45-degree field of view.
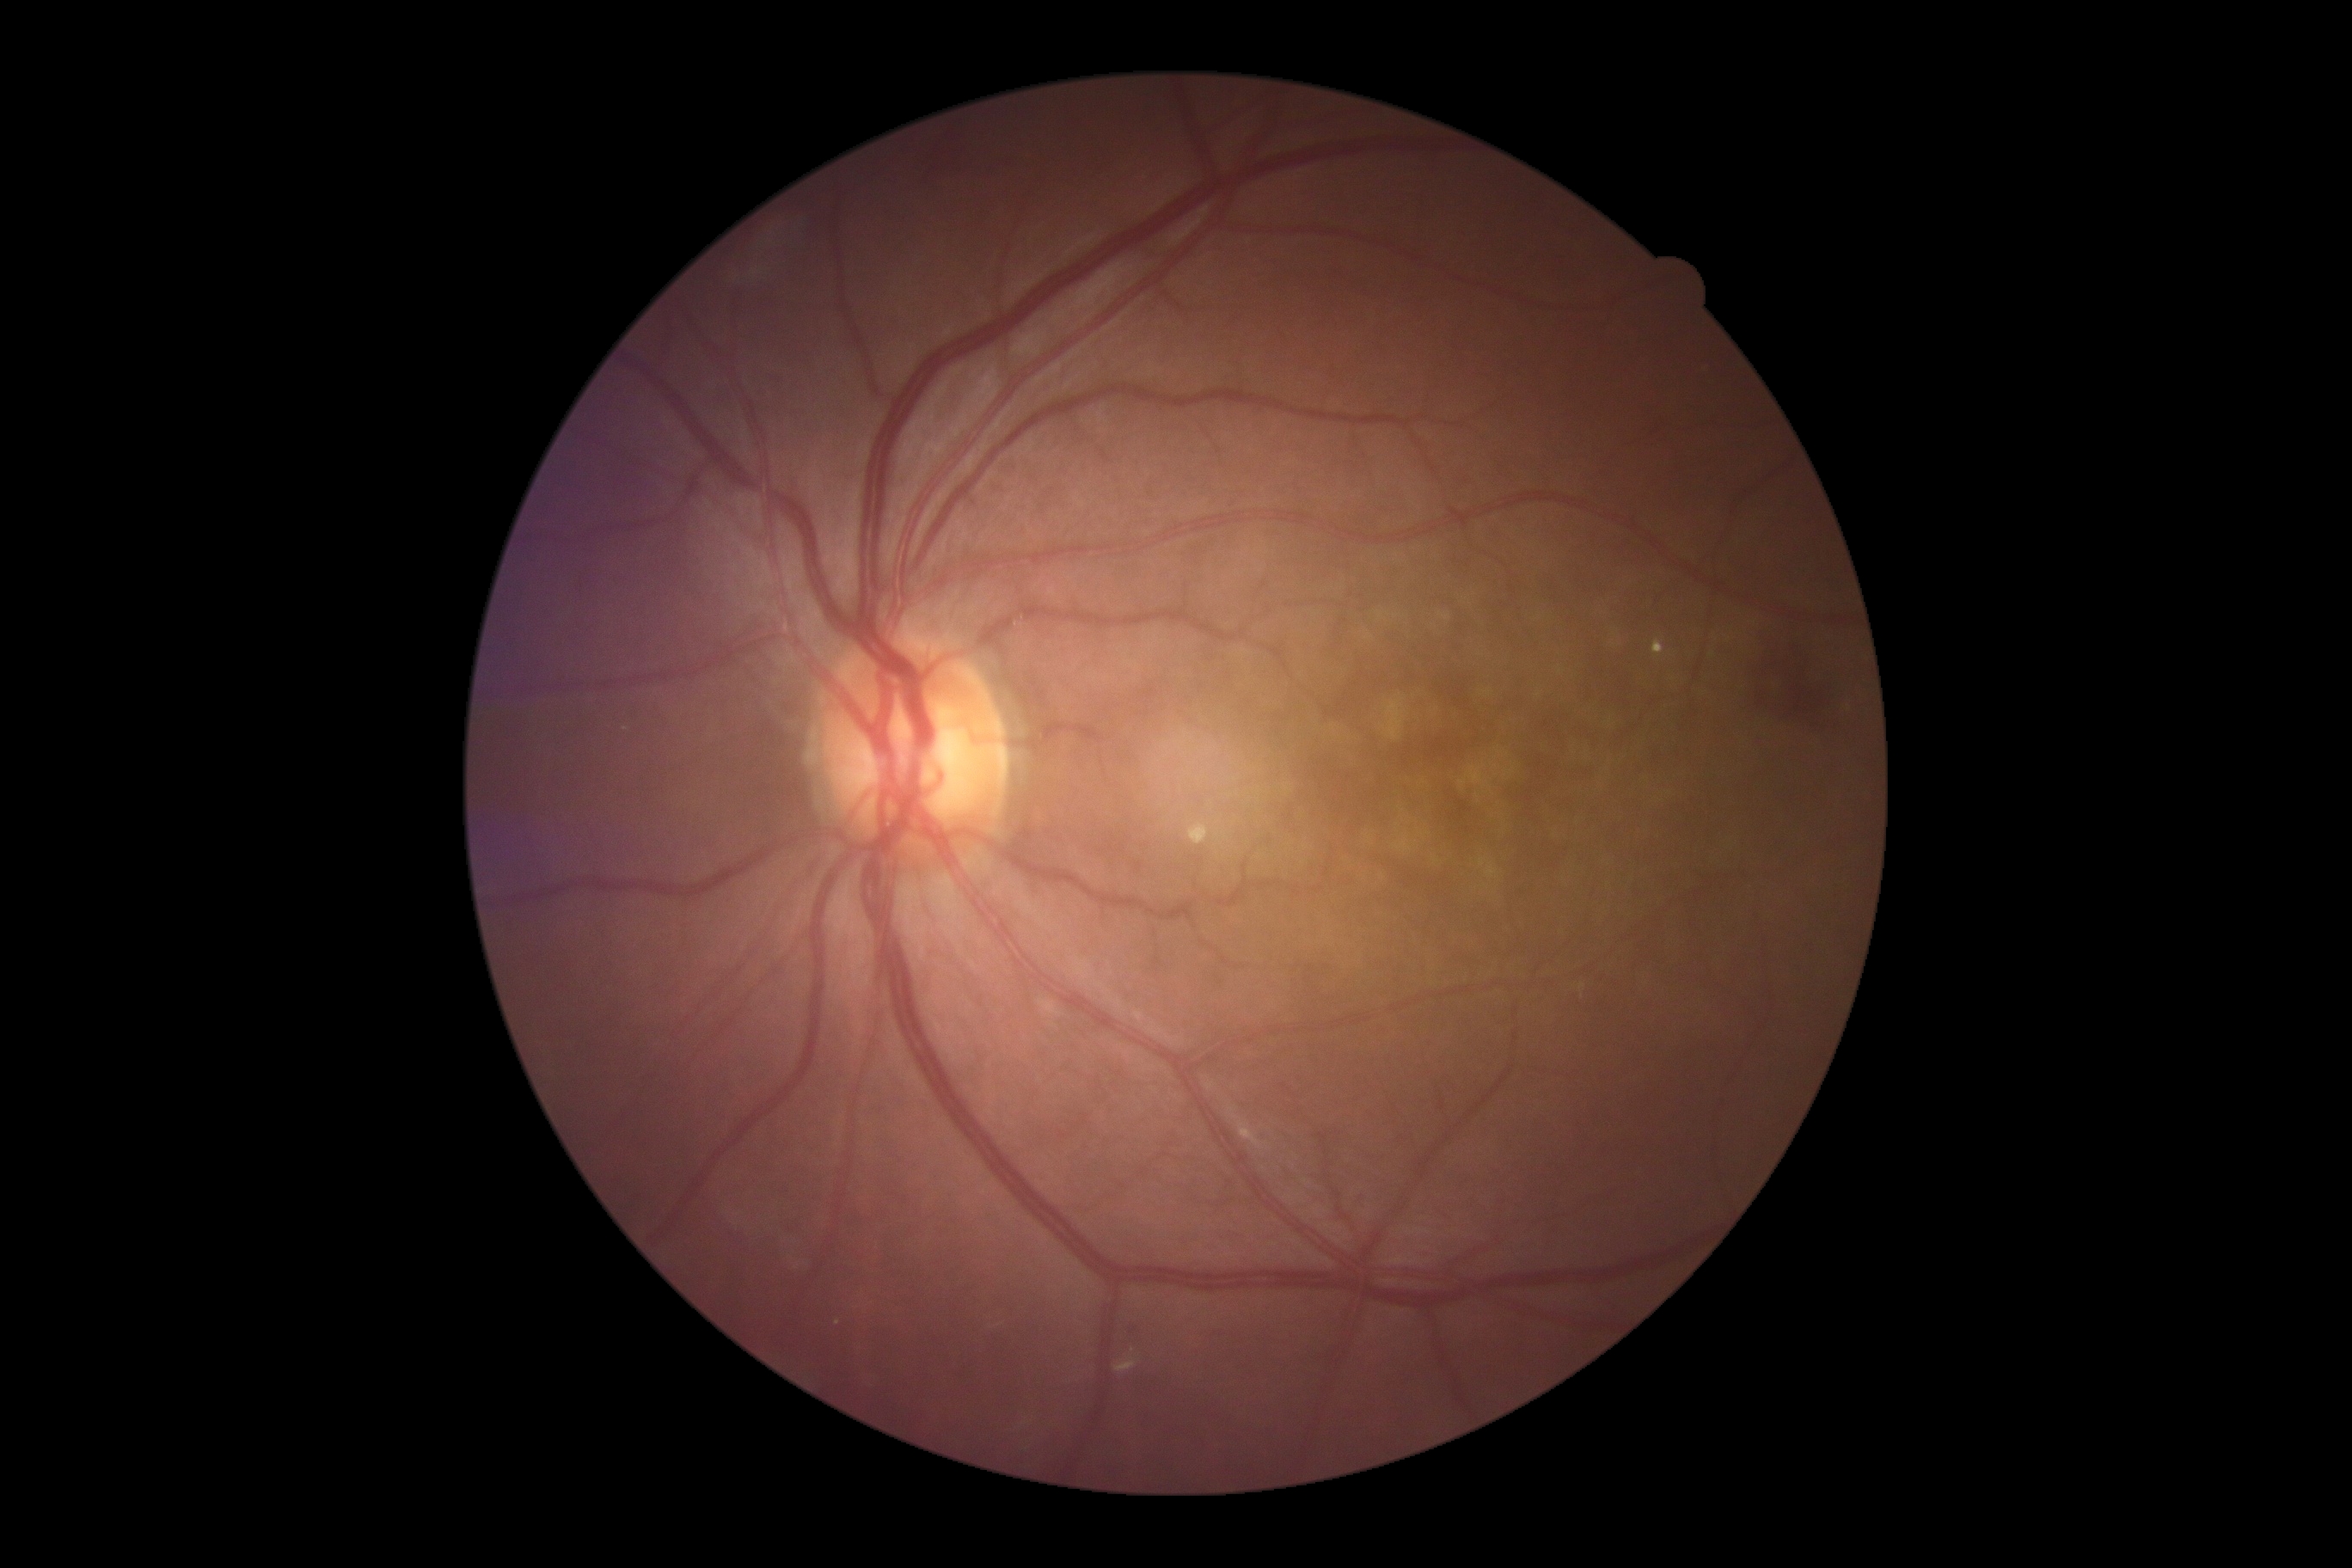
  dr_category: non-proliferative diabetic retinopathy
  dr_grade: 2